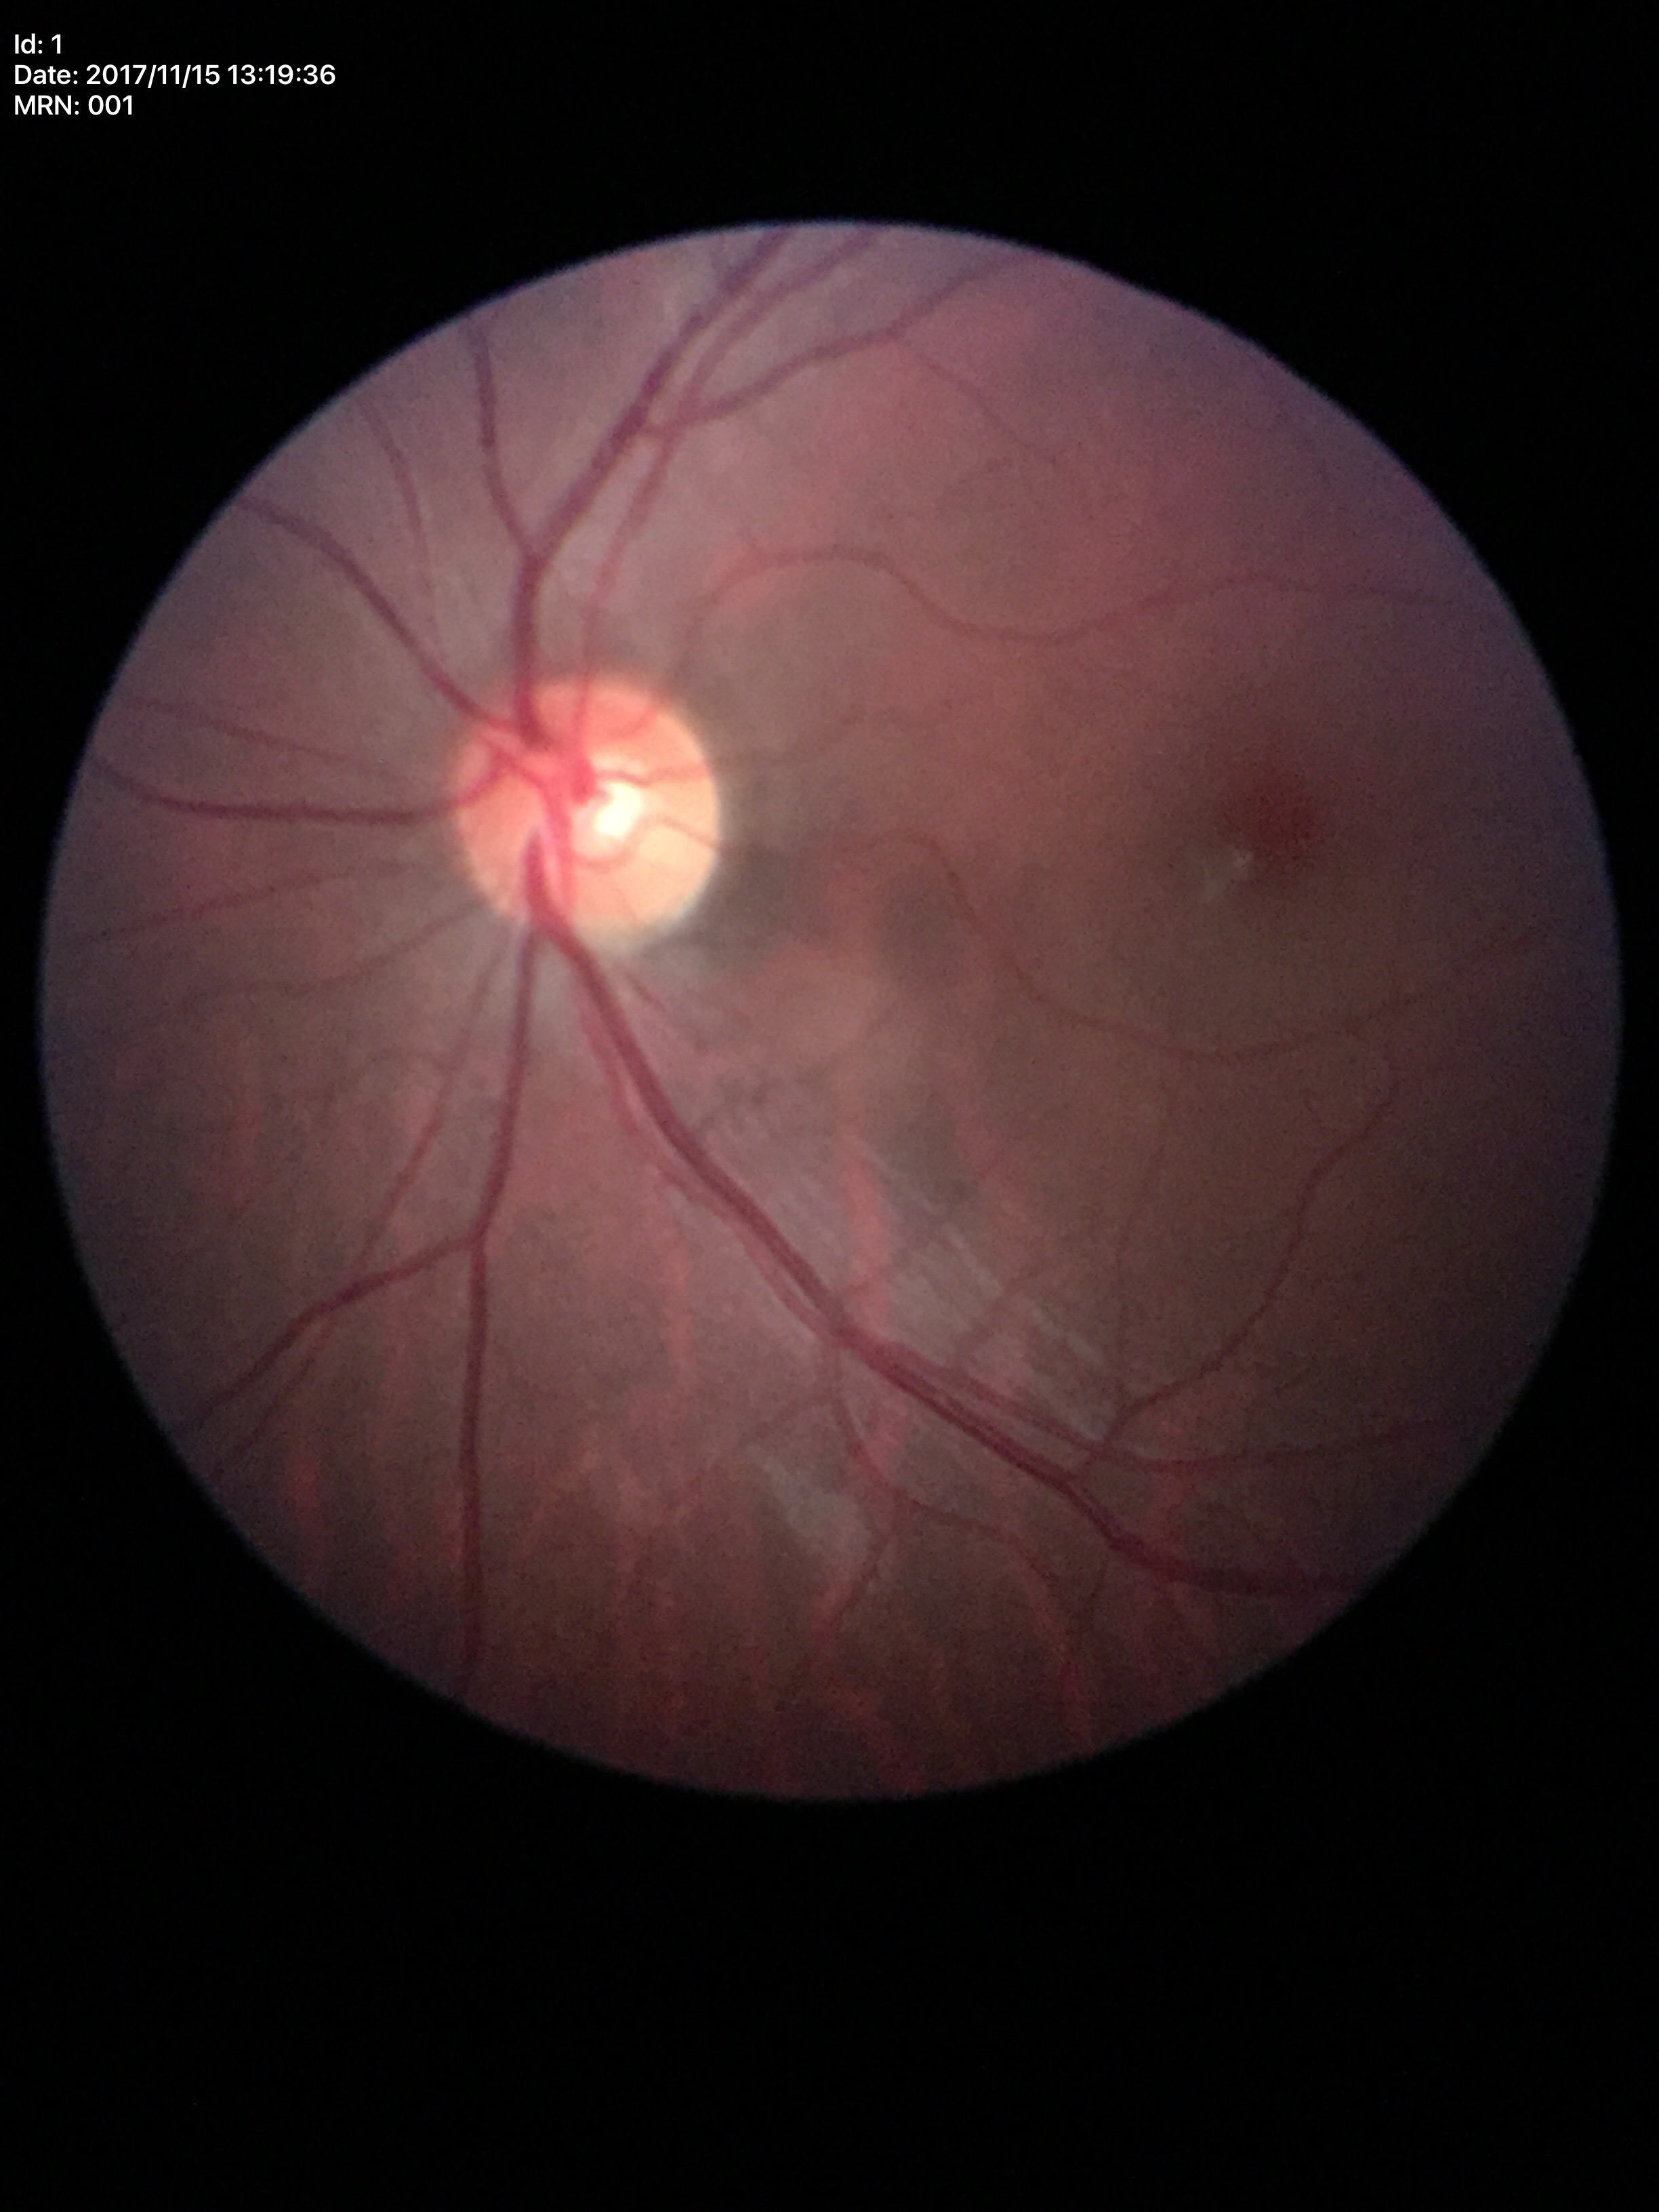 Findings:
• area cup-disc ratio · 0.23
• horizontal cup-disc ratio · 0.48
• Glaucoma screening · not suspect (all 5 graders called normal)
• vertical cup-to-disc ratio · 0.49